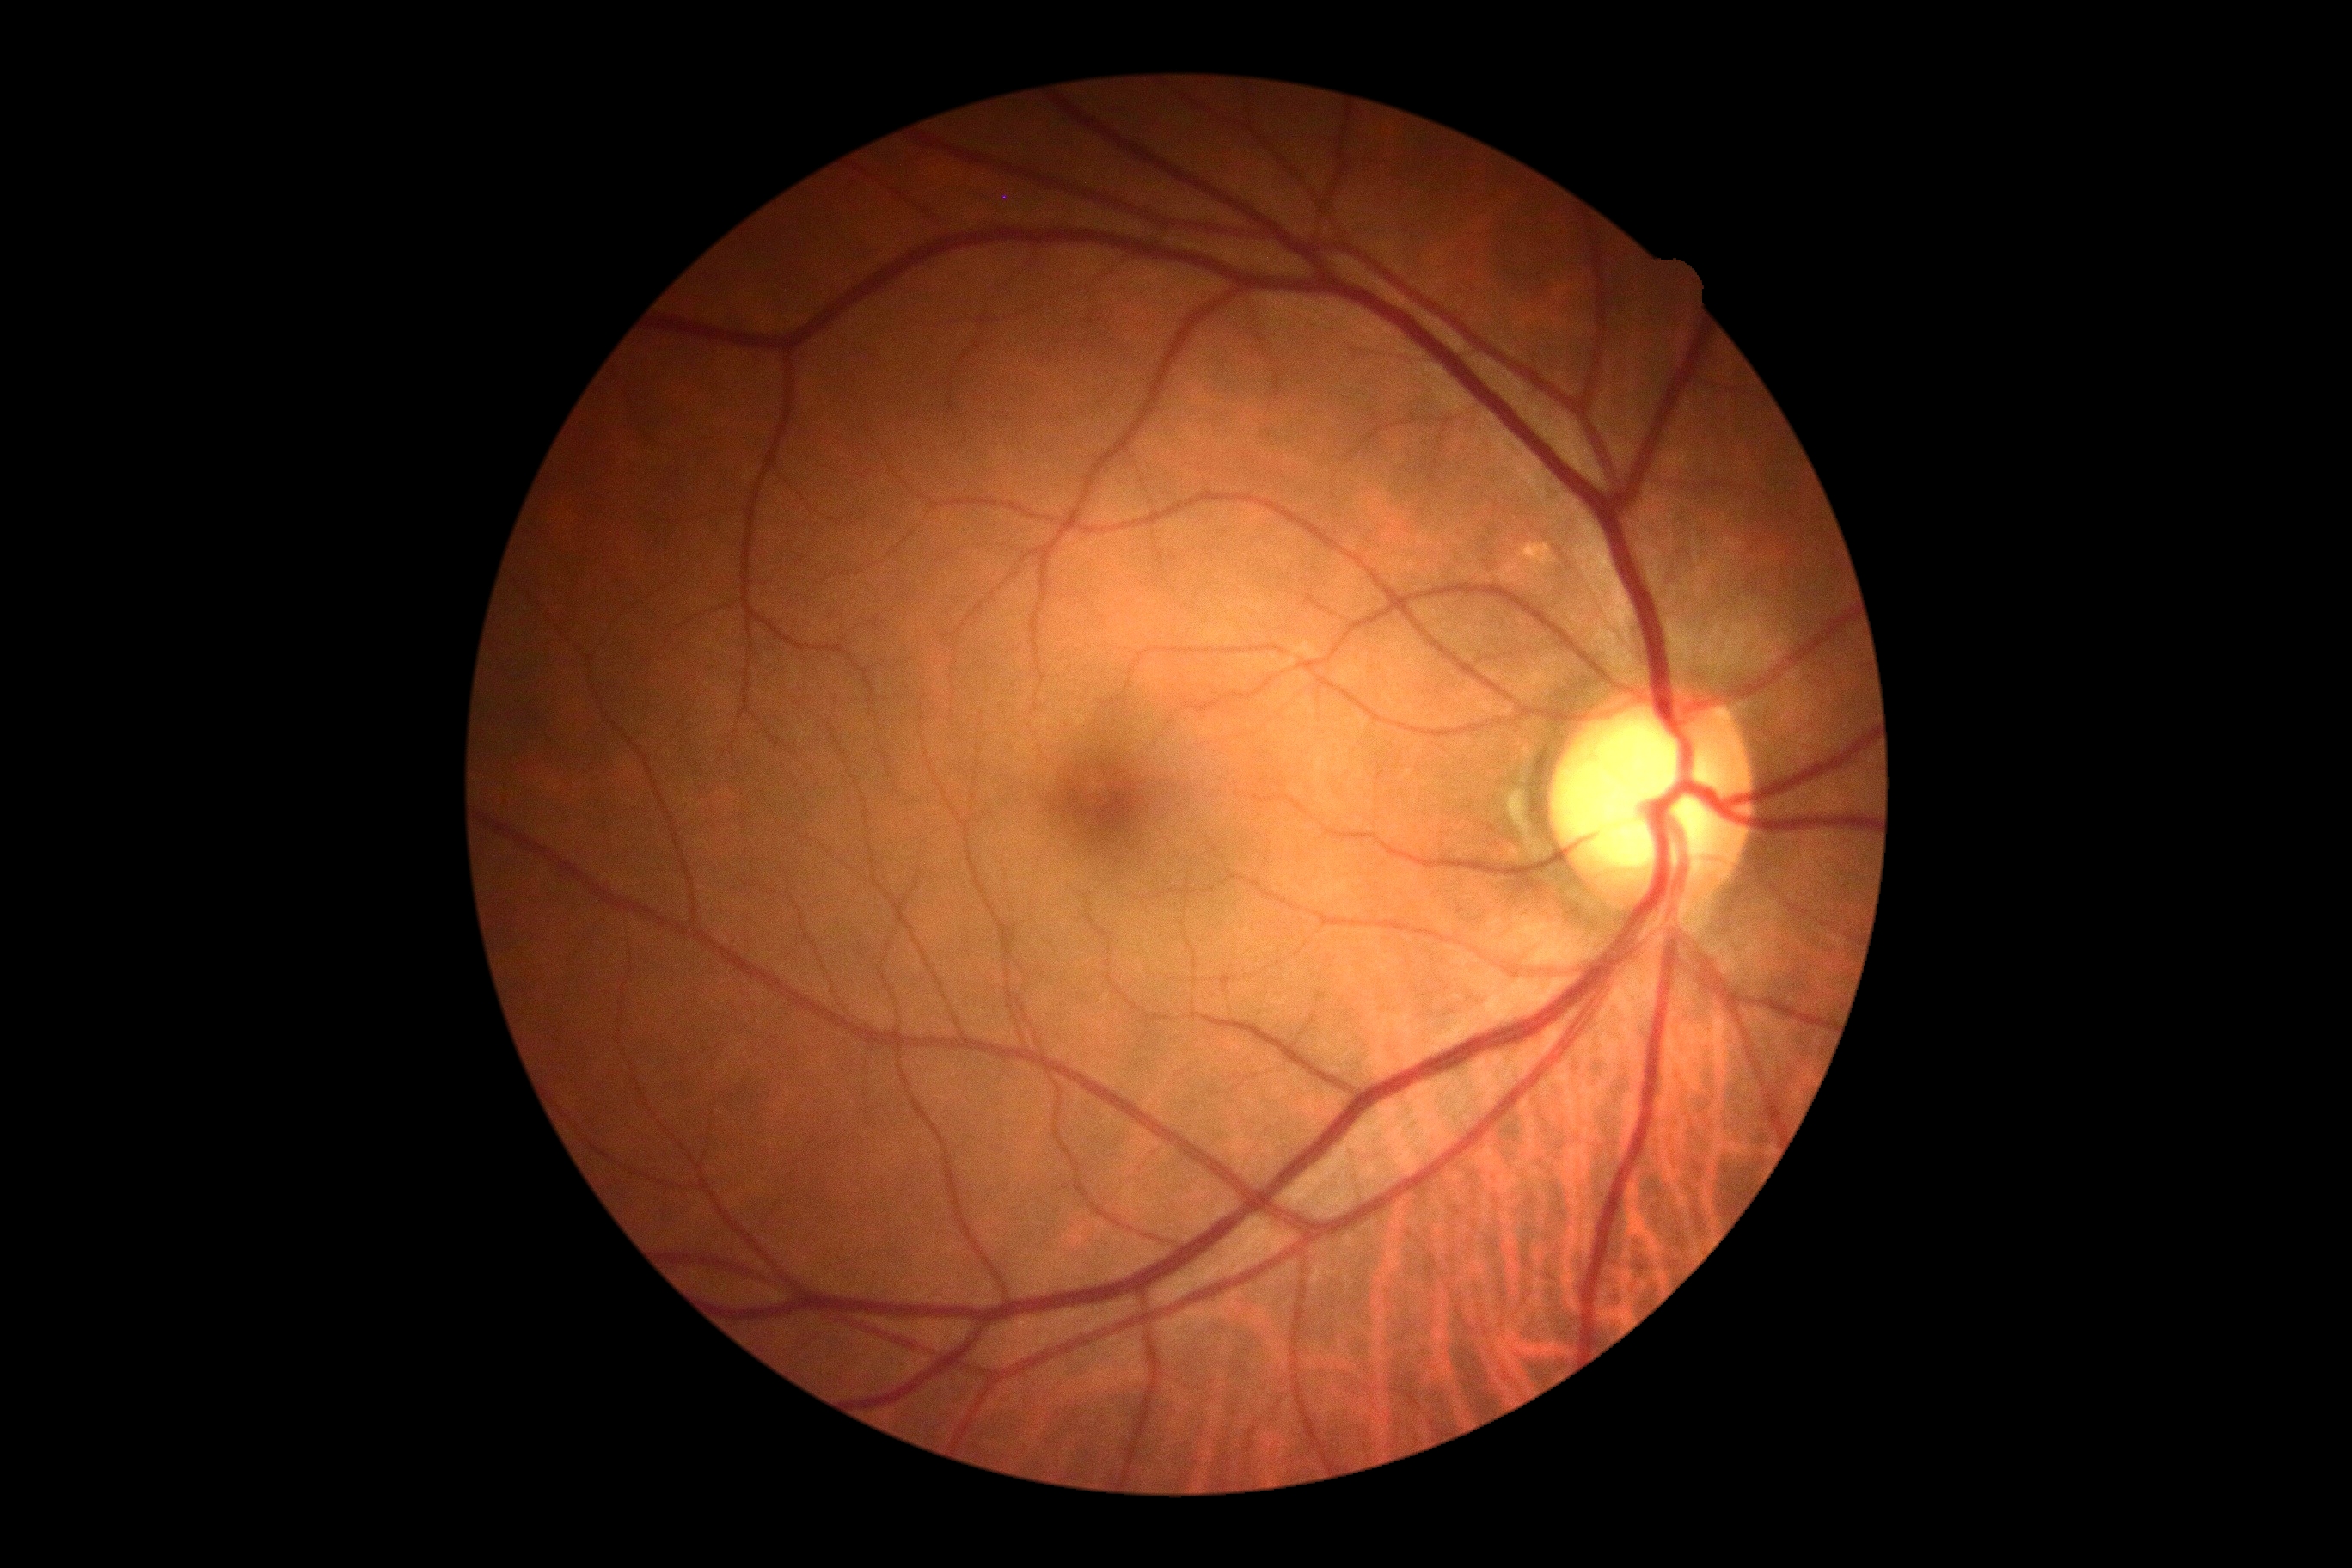
dr_grade: grade 0 (no apparent retinopathy)